Fundus photo. 748 by 717 pixels. 45° FOV.
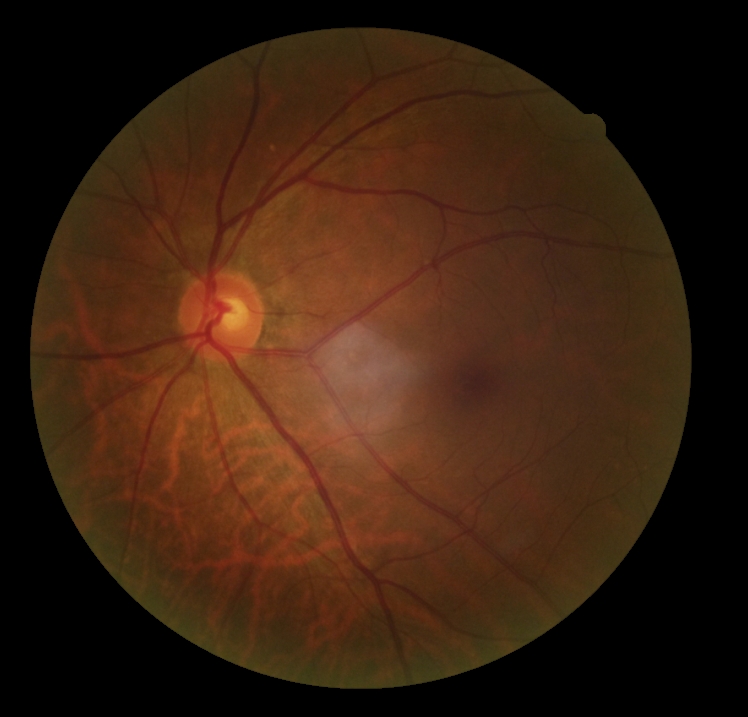
dr_grade: grade 0